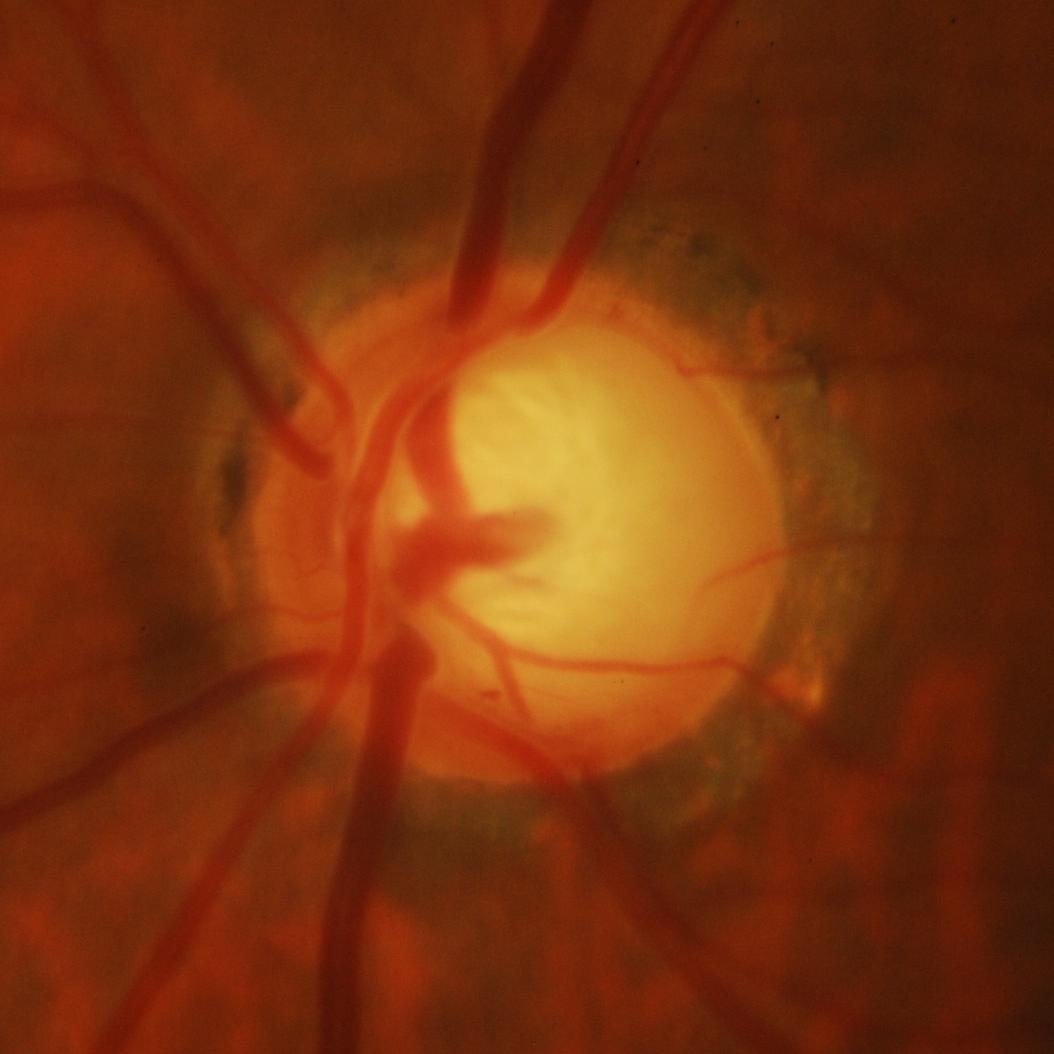

Glaucomatous optic neuropathy is present. Diagnosis: glaucomatous findings.